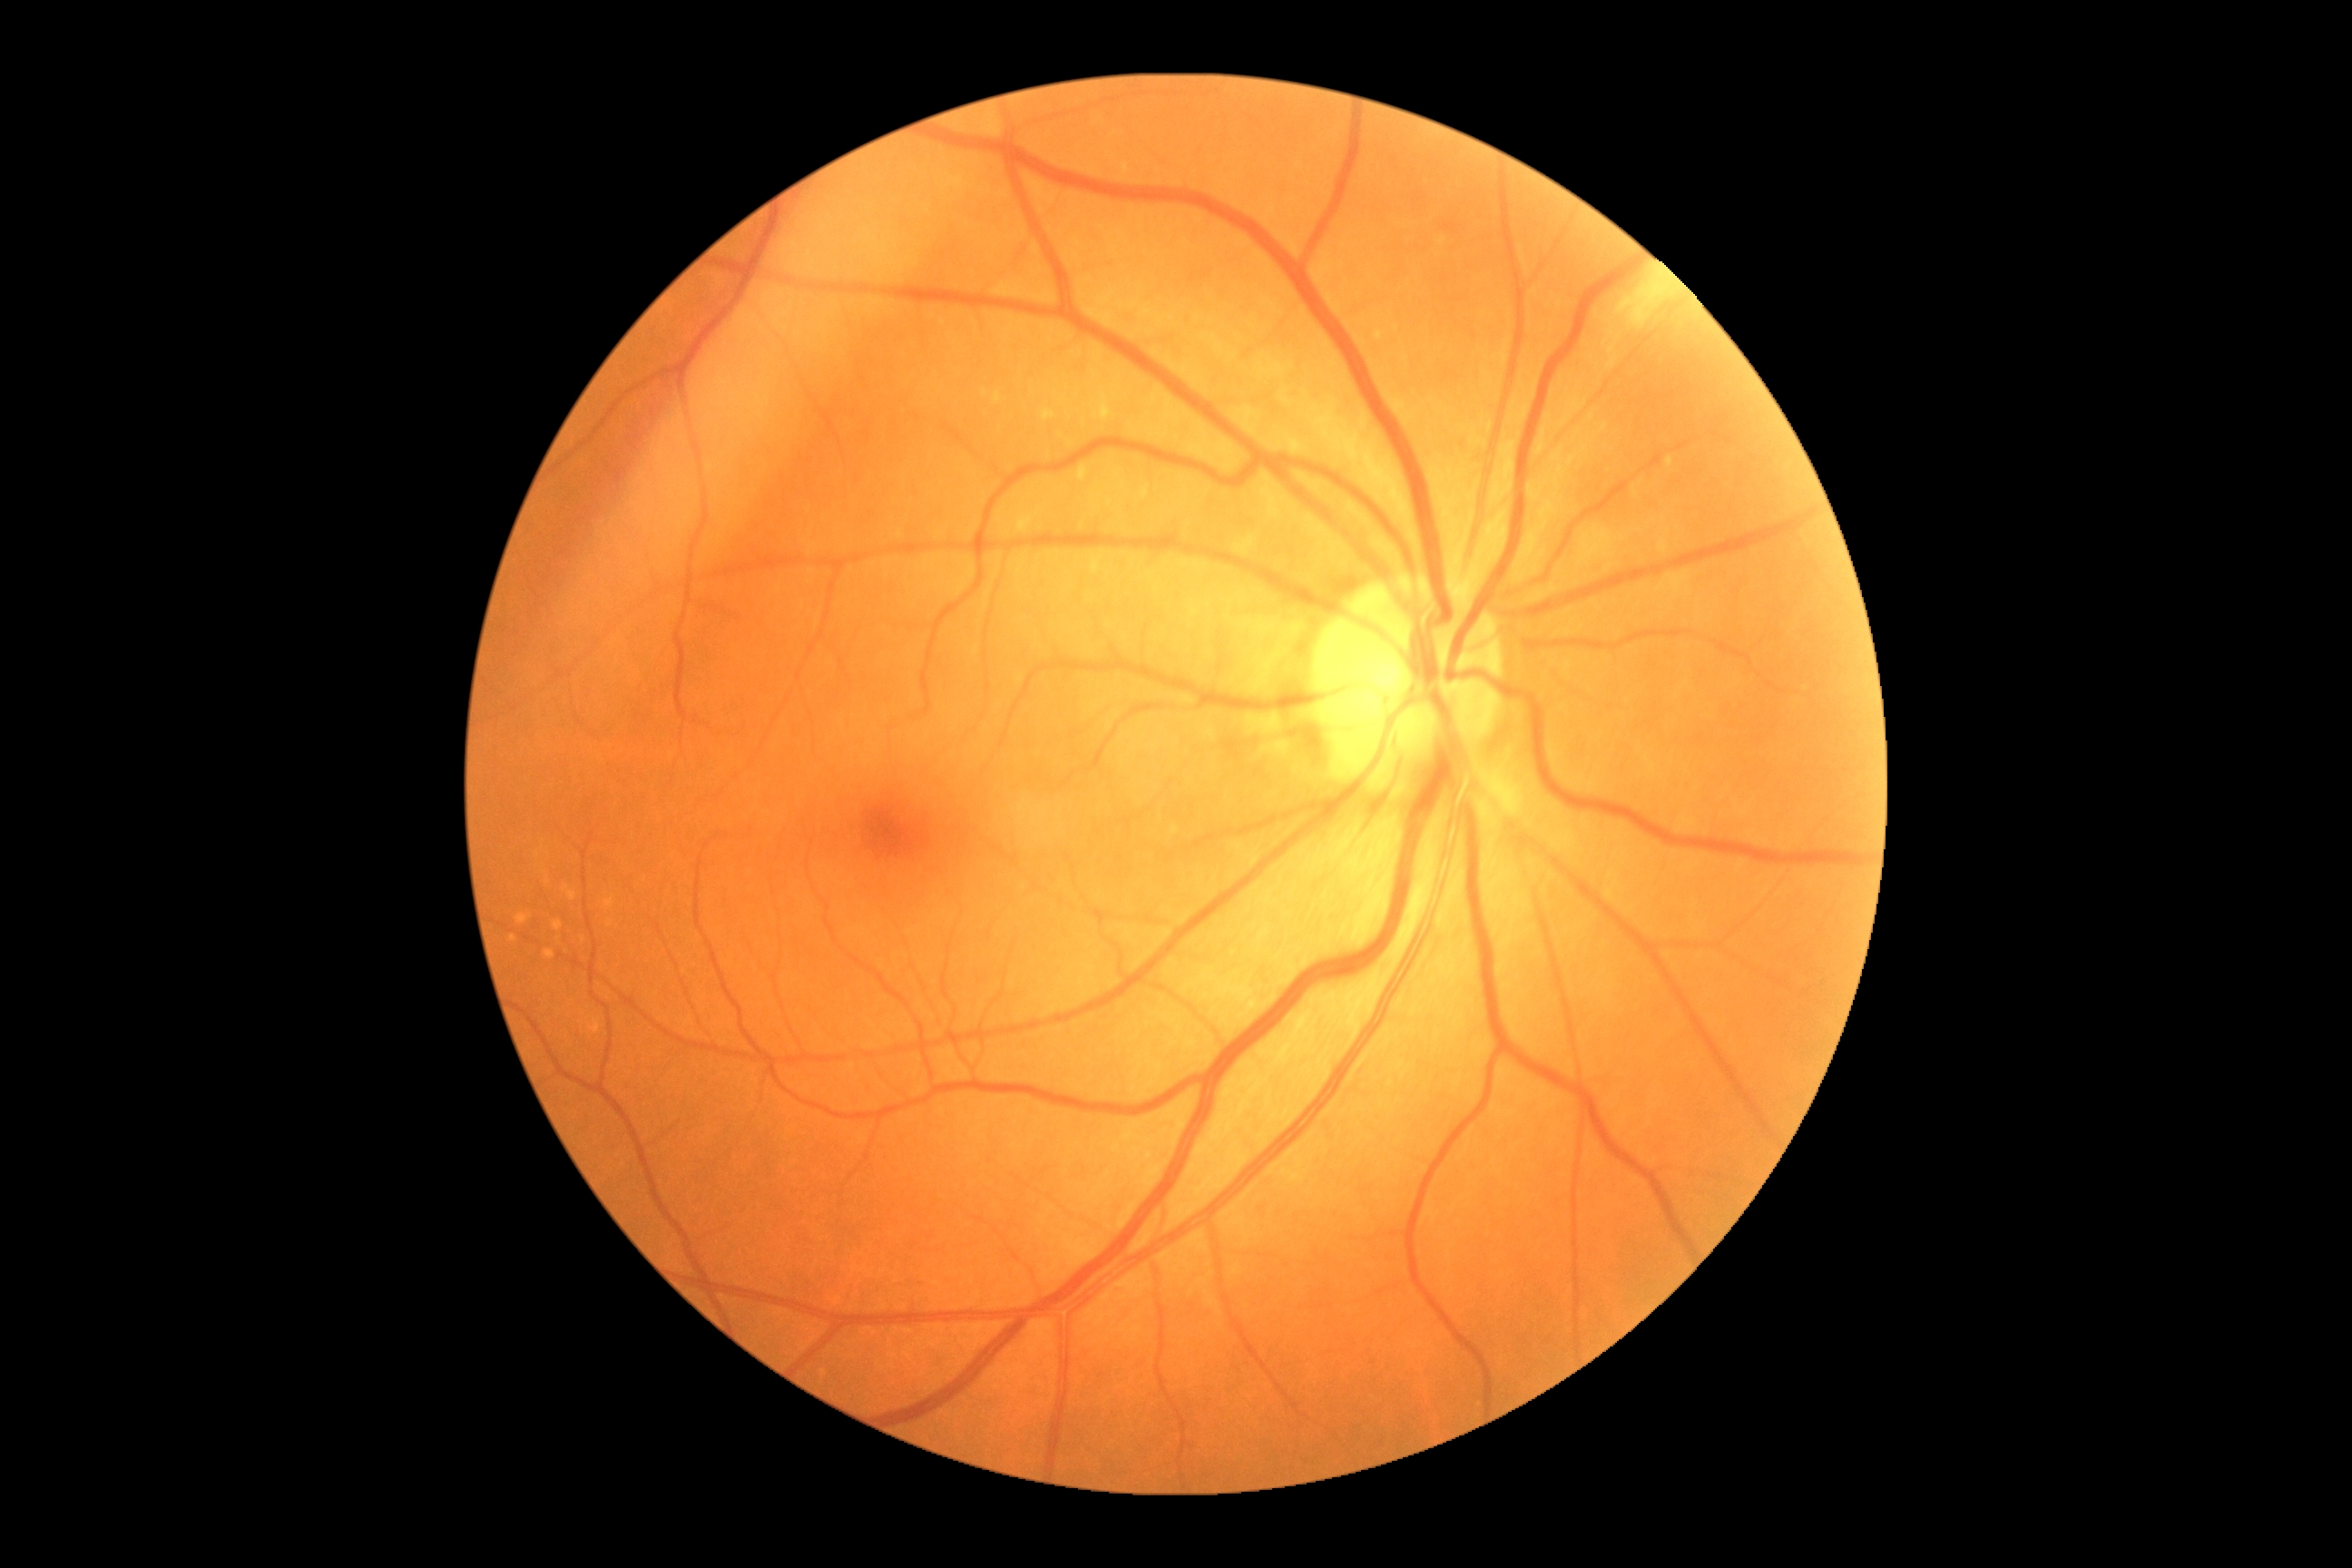

Diabetic retinopathy grade: 0/4.